Color fundus image · 45-degree field of view · 2212x1659px:
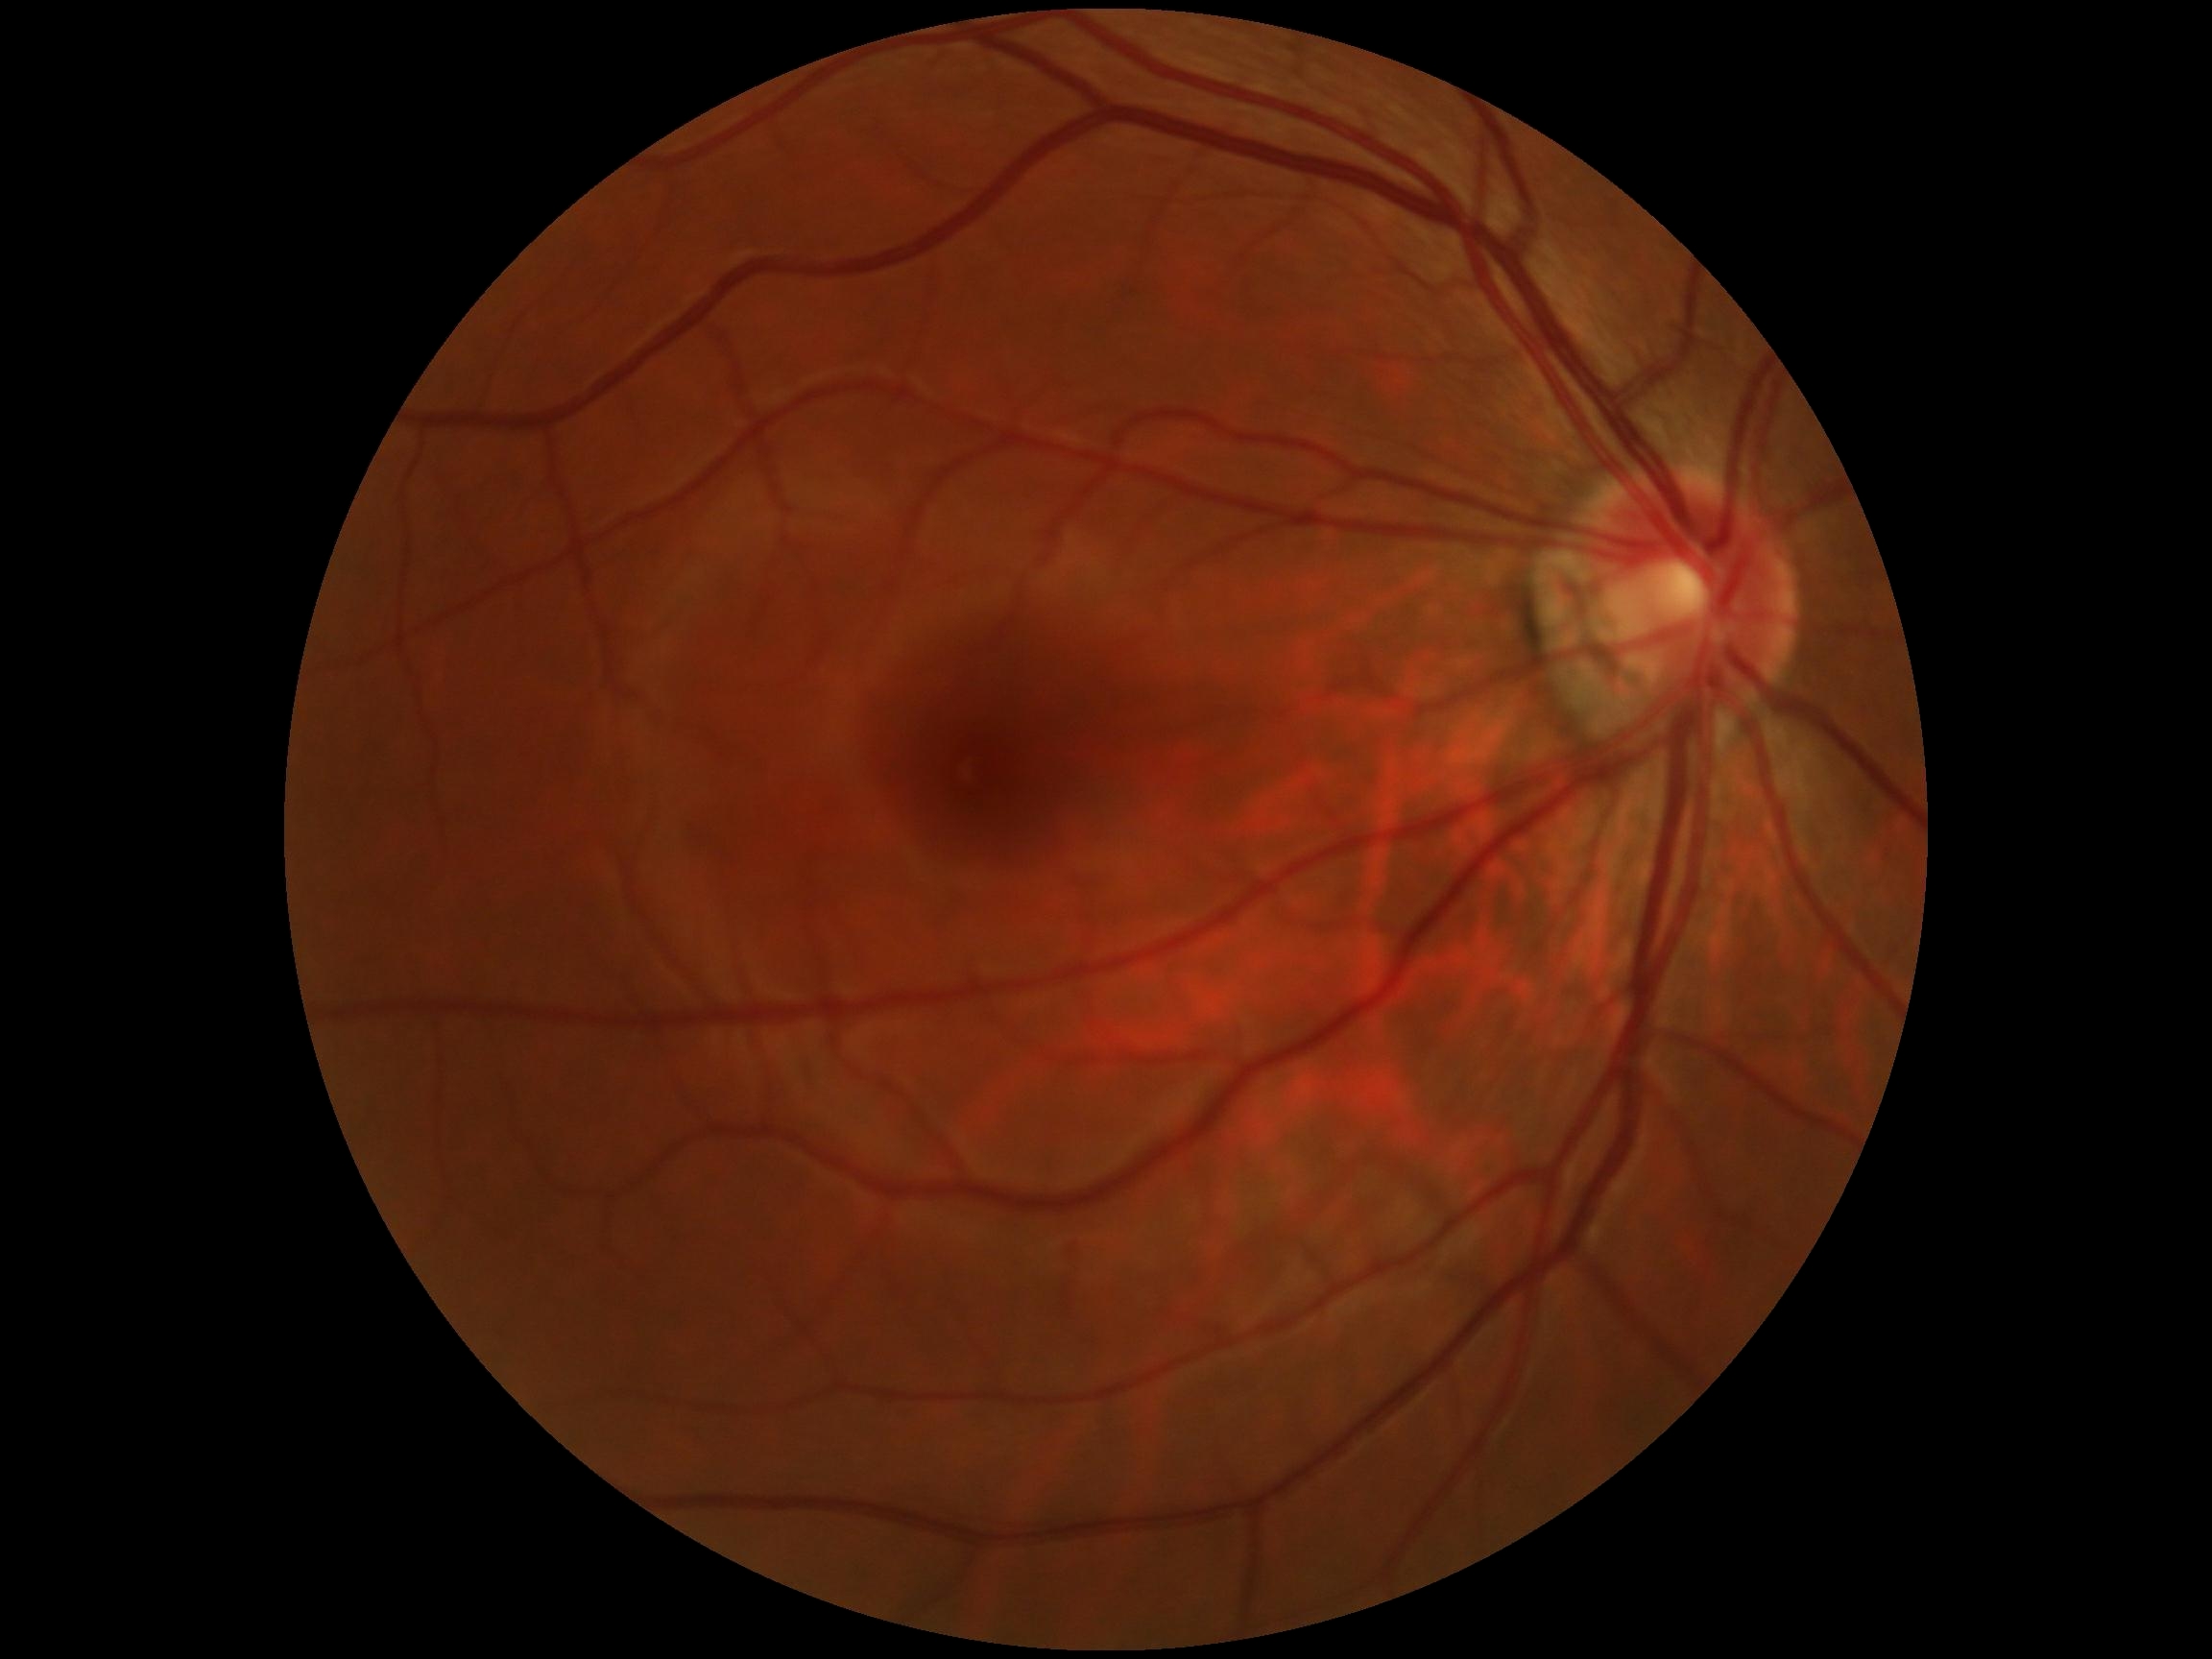
diabetic retinopathy grade = 0.